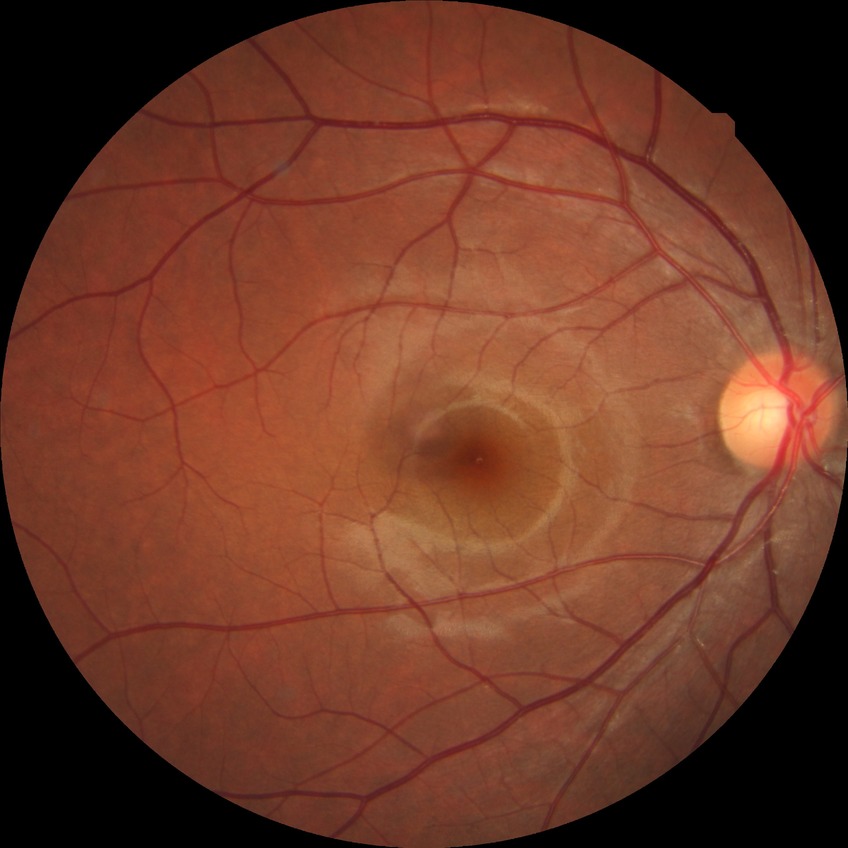
retinopathy grade: no diabetic retinopathy.